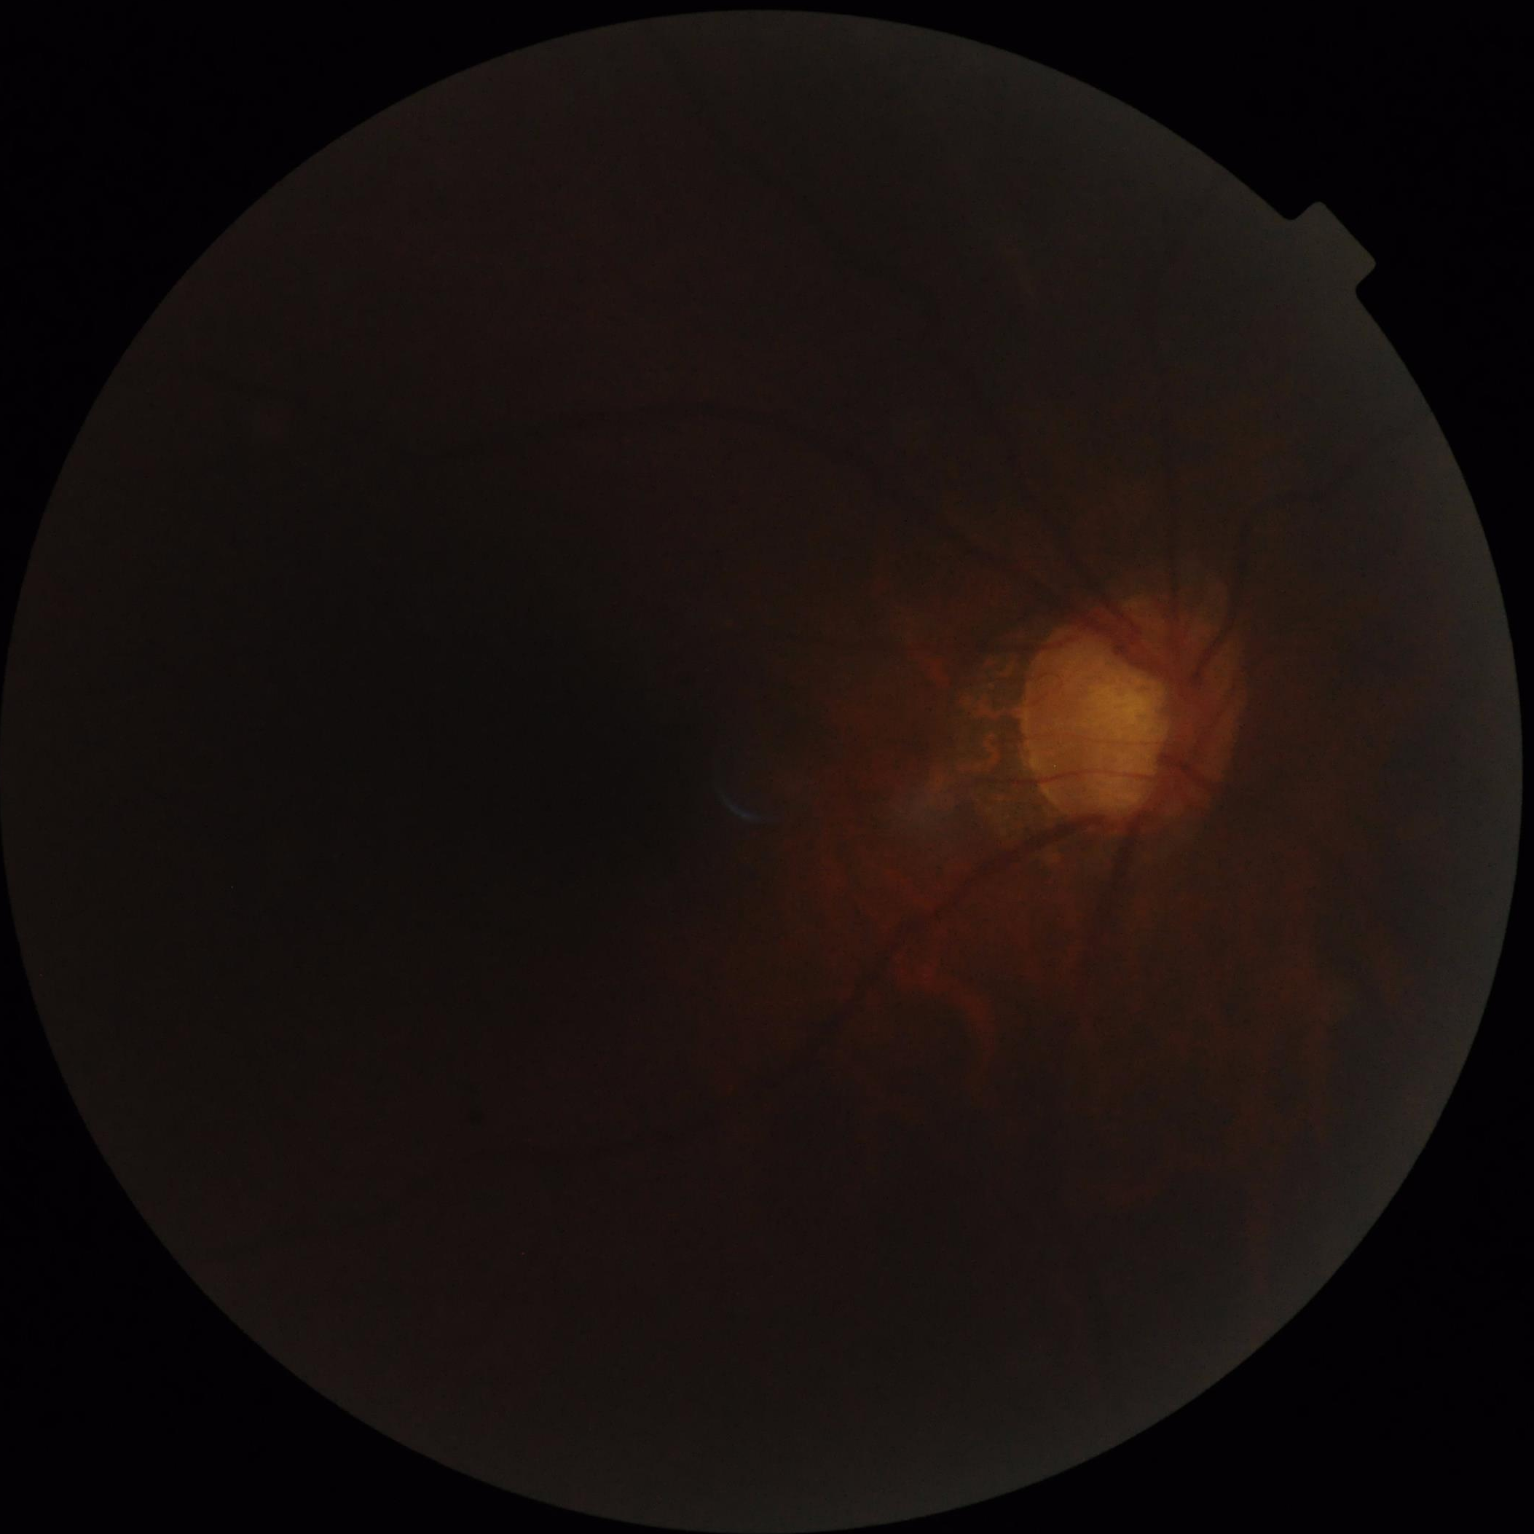
Overall image quality is poor.
Poor illumination with uneven exposure.
Out of focus; structures are indistinct.
Contrast is low.